Fundus image cropped to the optic disc.
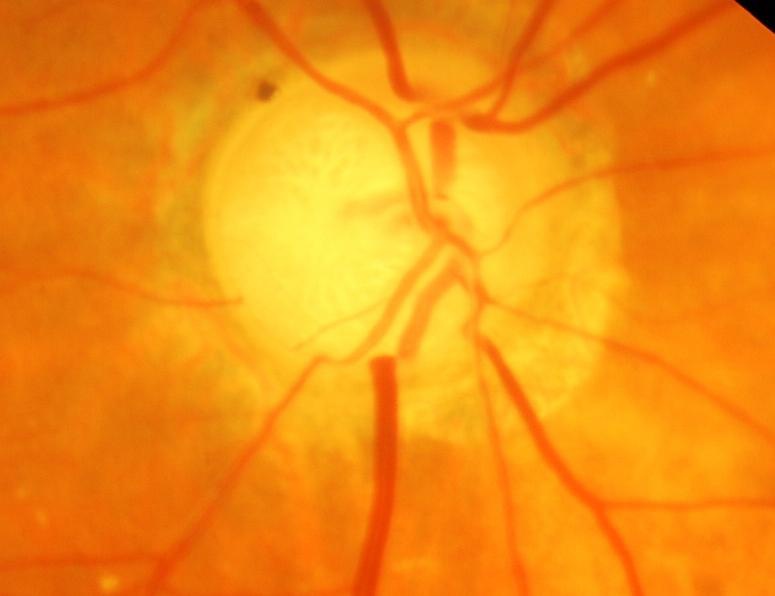 Glaucoma diagnosis = glaucomatous changes.